Handheld portable fundus camera image:
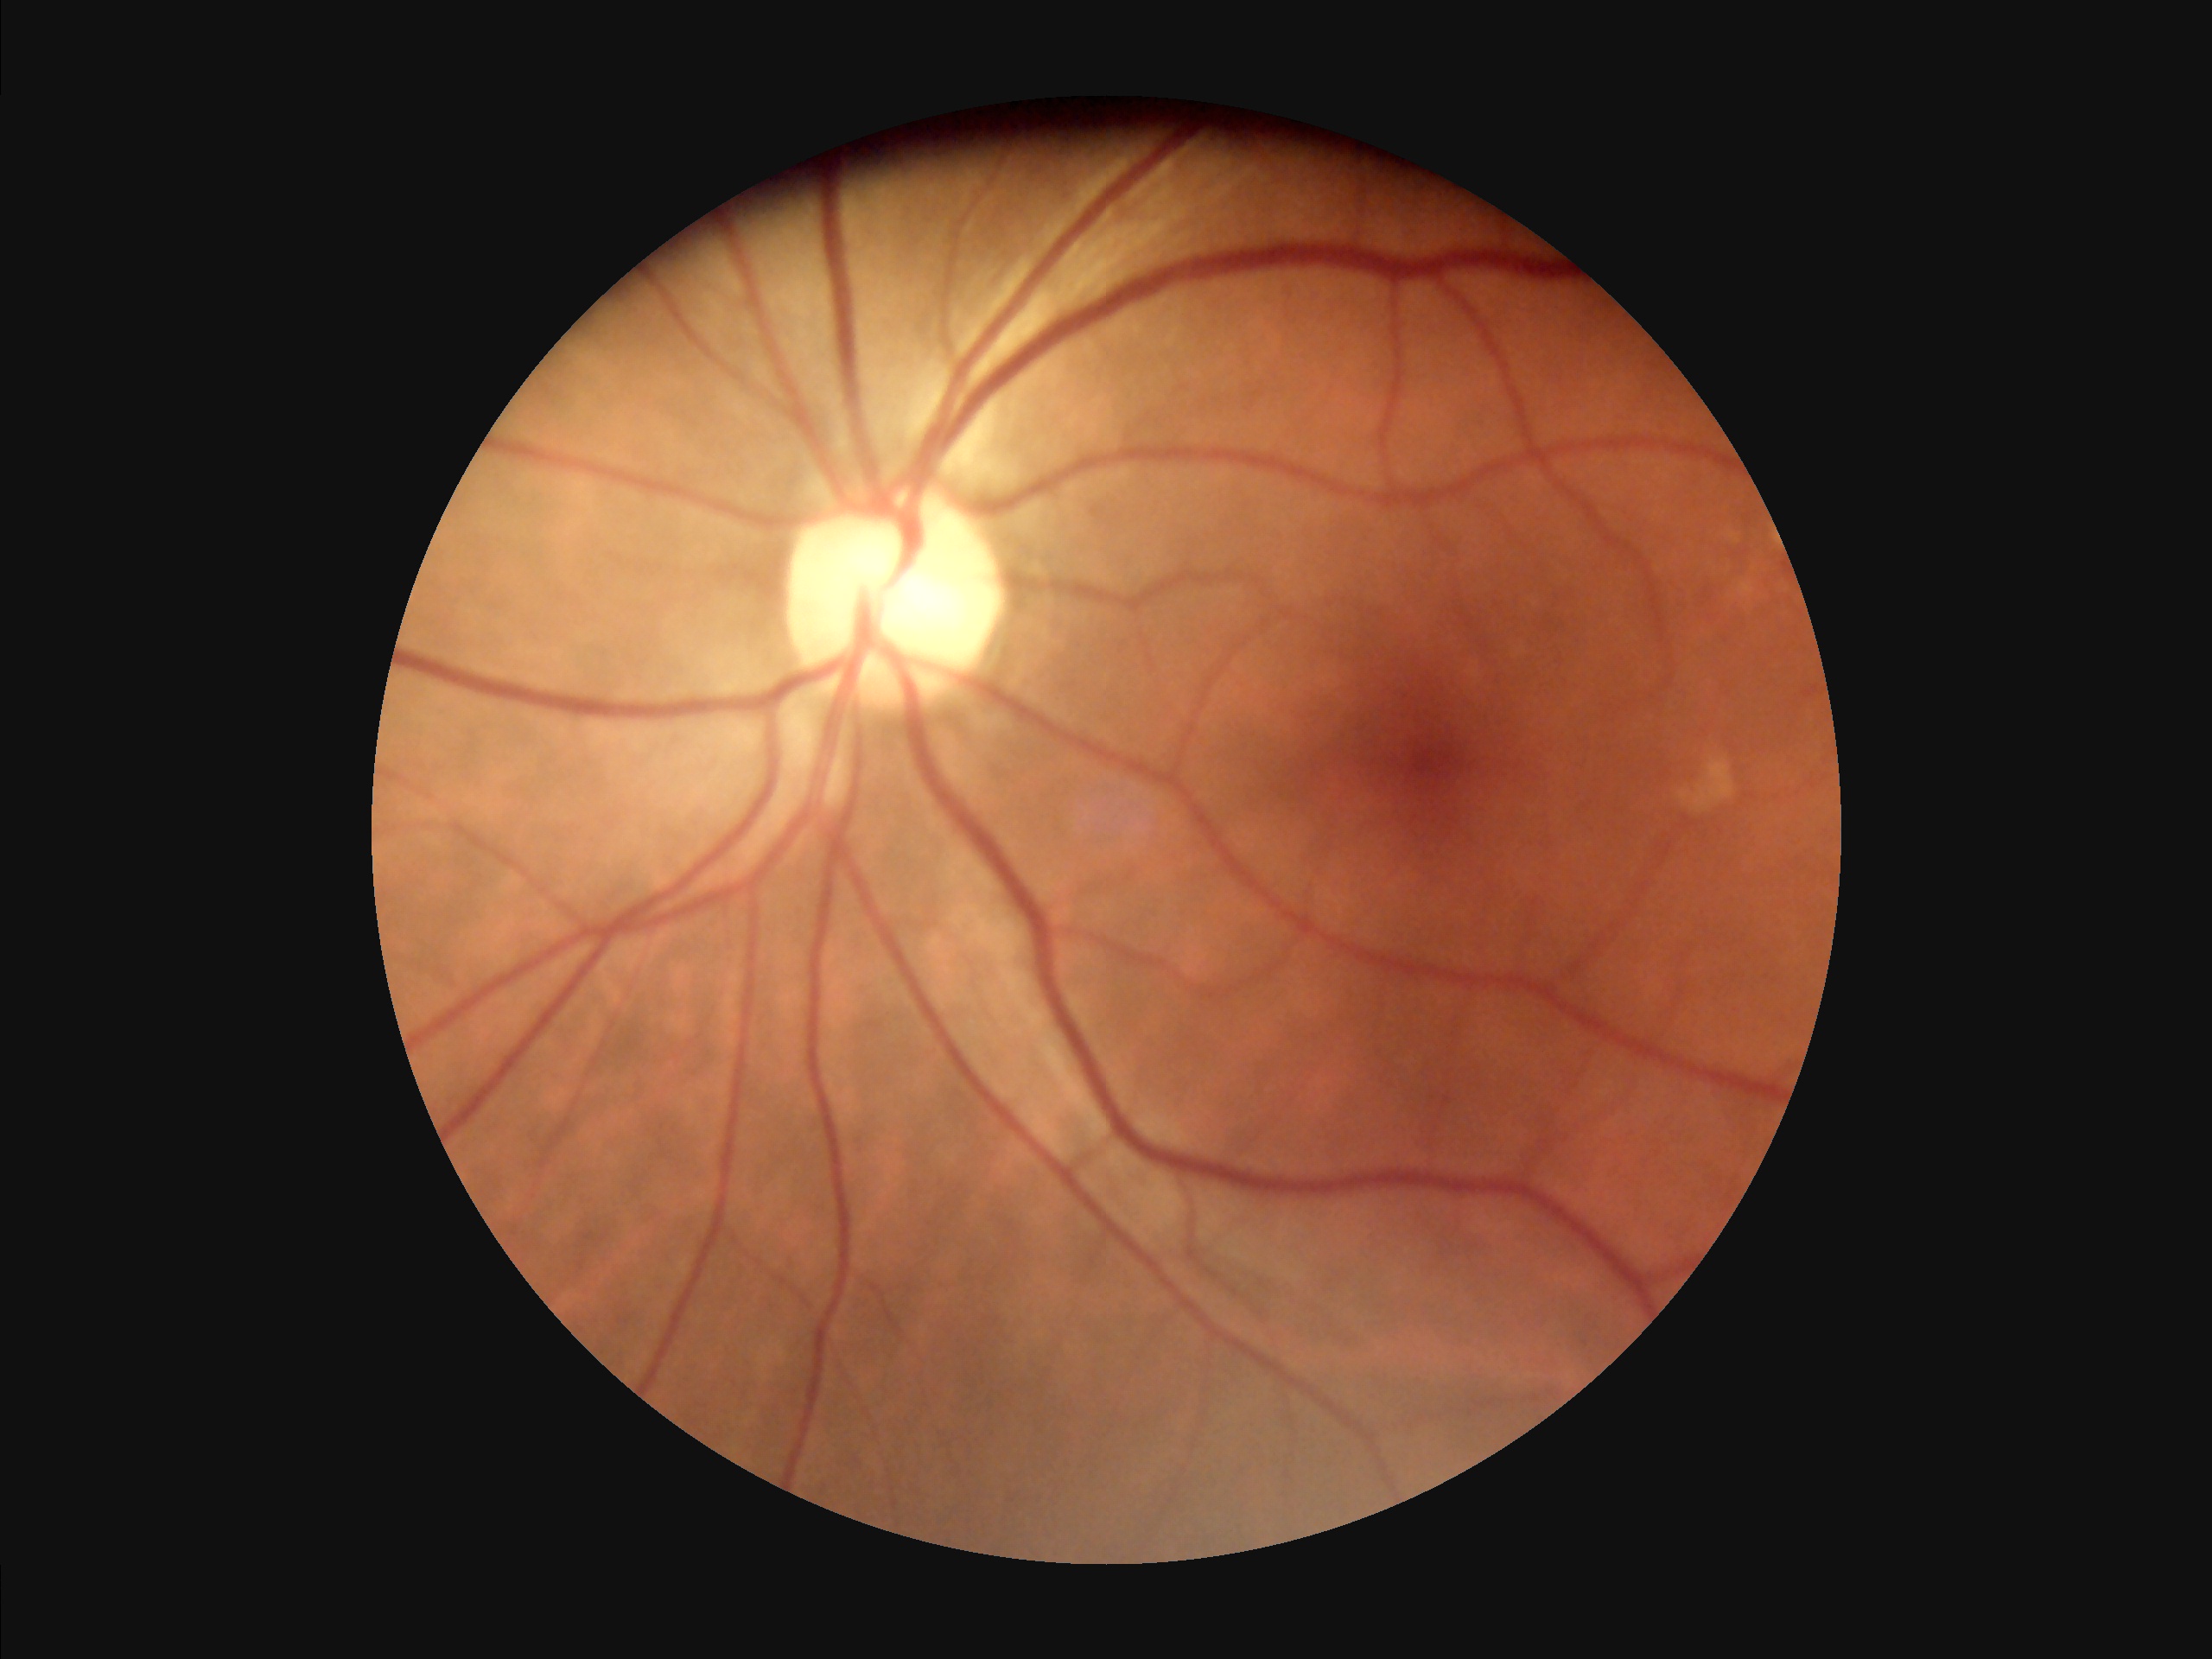

Overall image quality is good.